Posterior pole photograph. Without pupil dilation. NIDEK AFC-230. 848 by 848 pixels
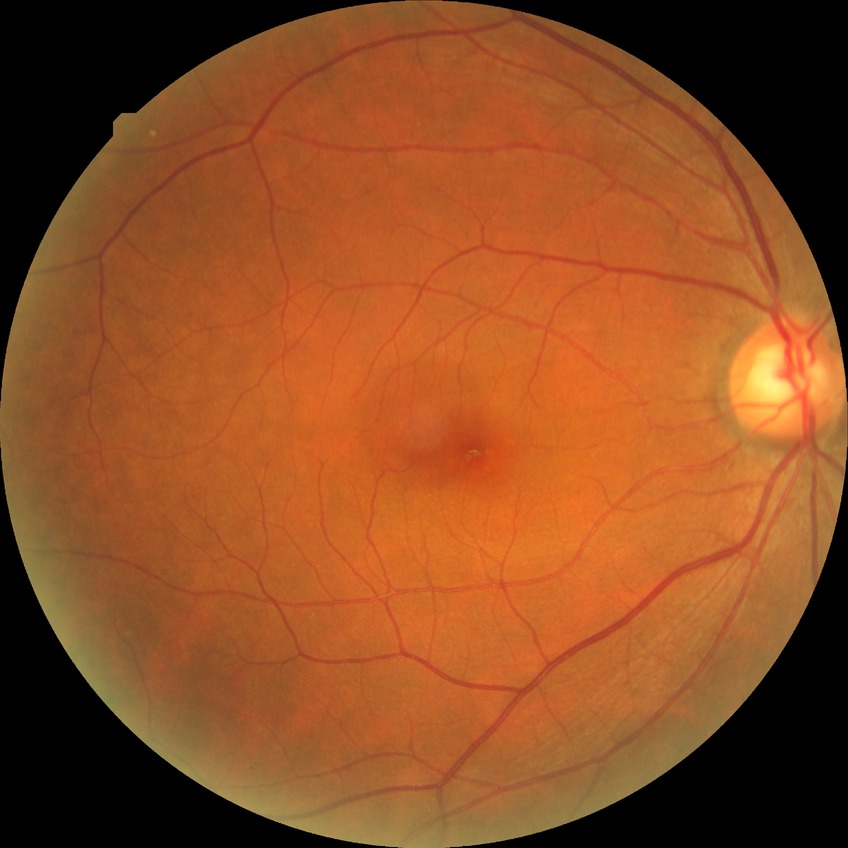
Davis grading: no diabetic retinopathy.